Pediatric wide-field fundus photograph. 1240x1240px
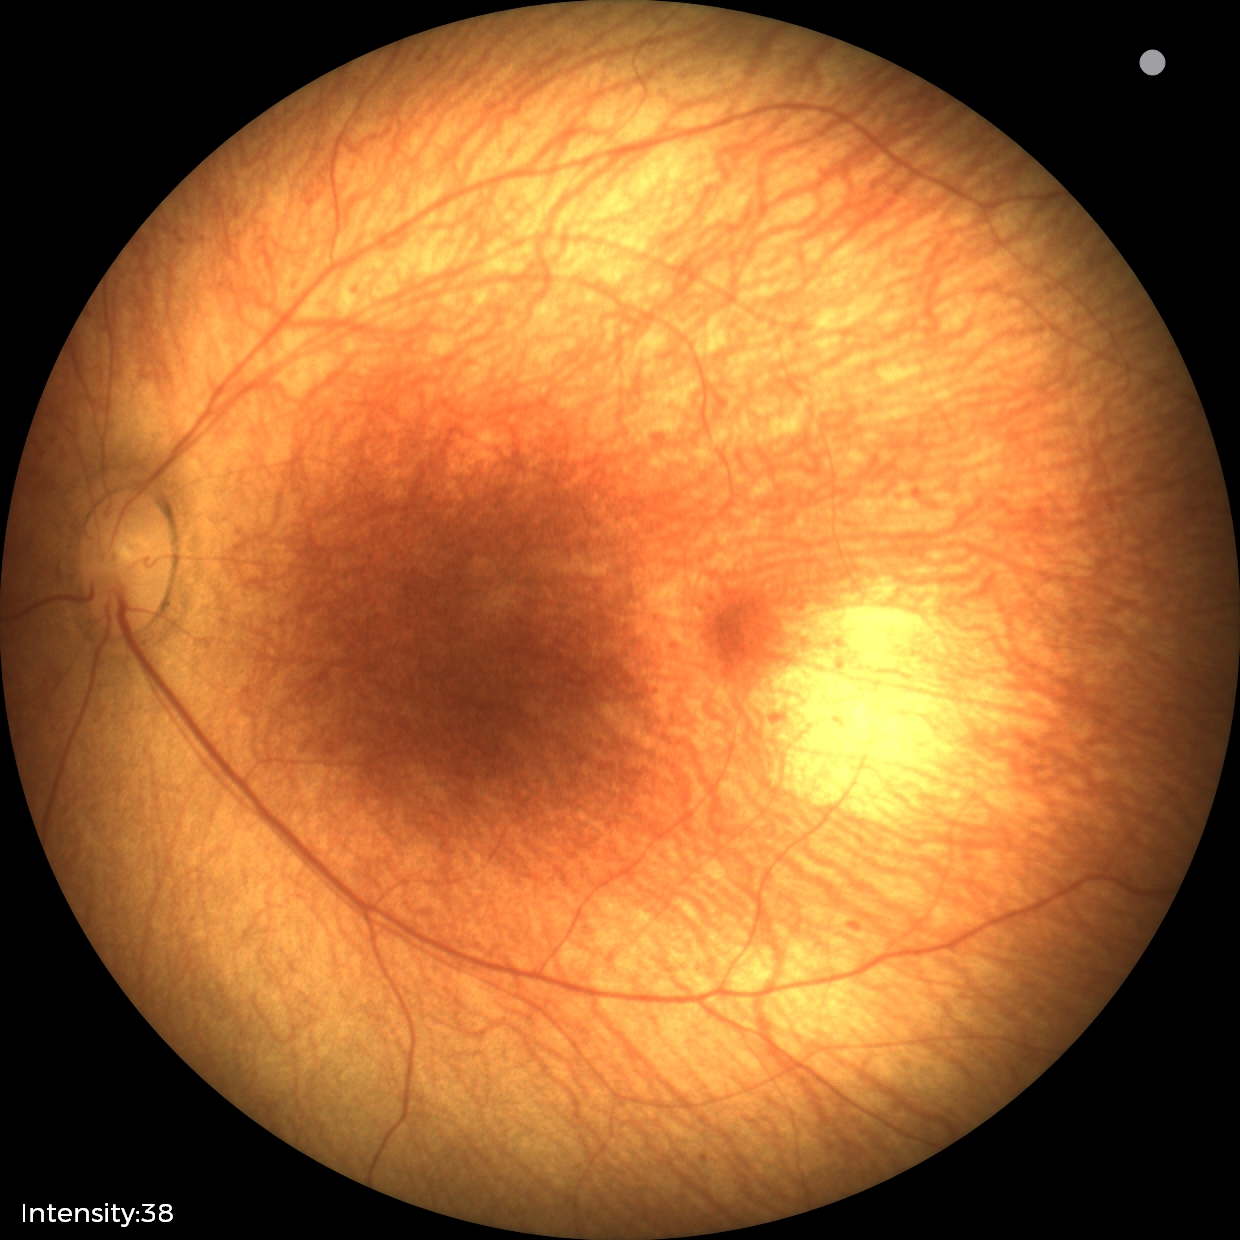

Diagnosis = no pathology identified.